45° FOV: 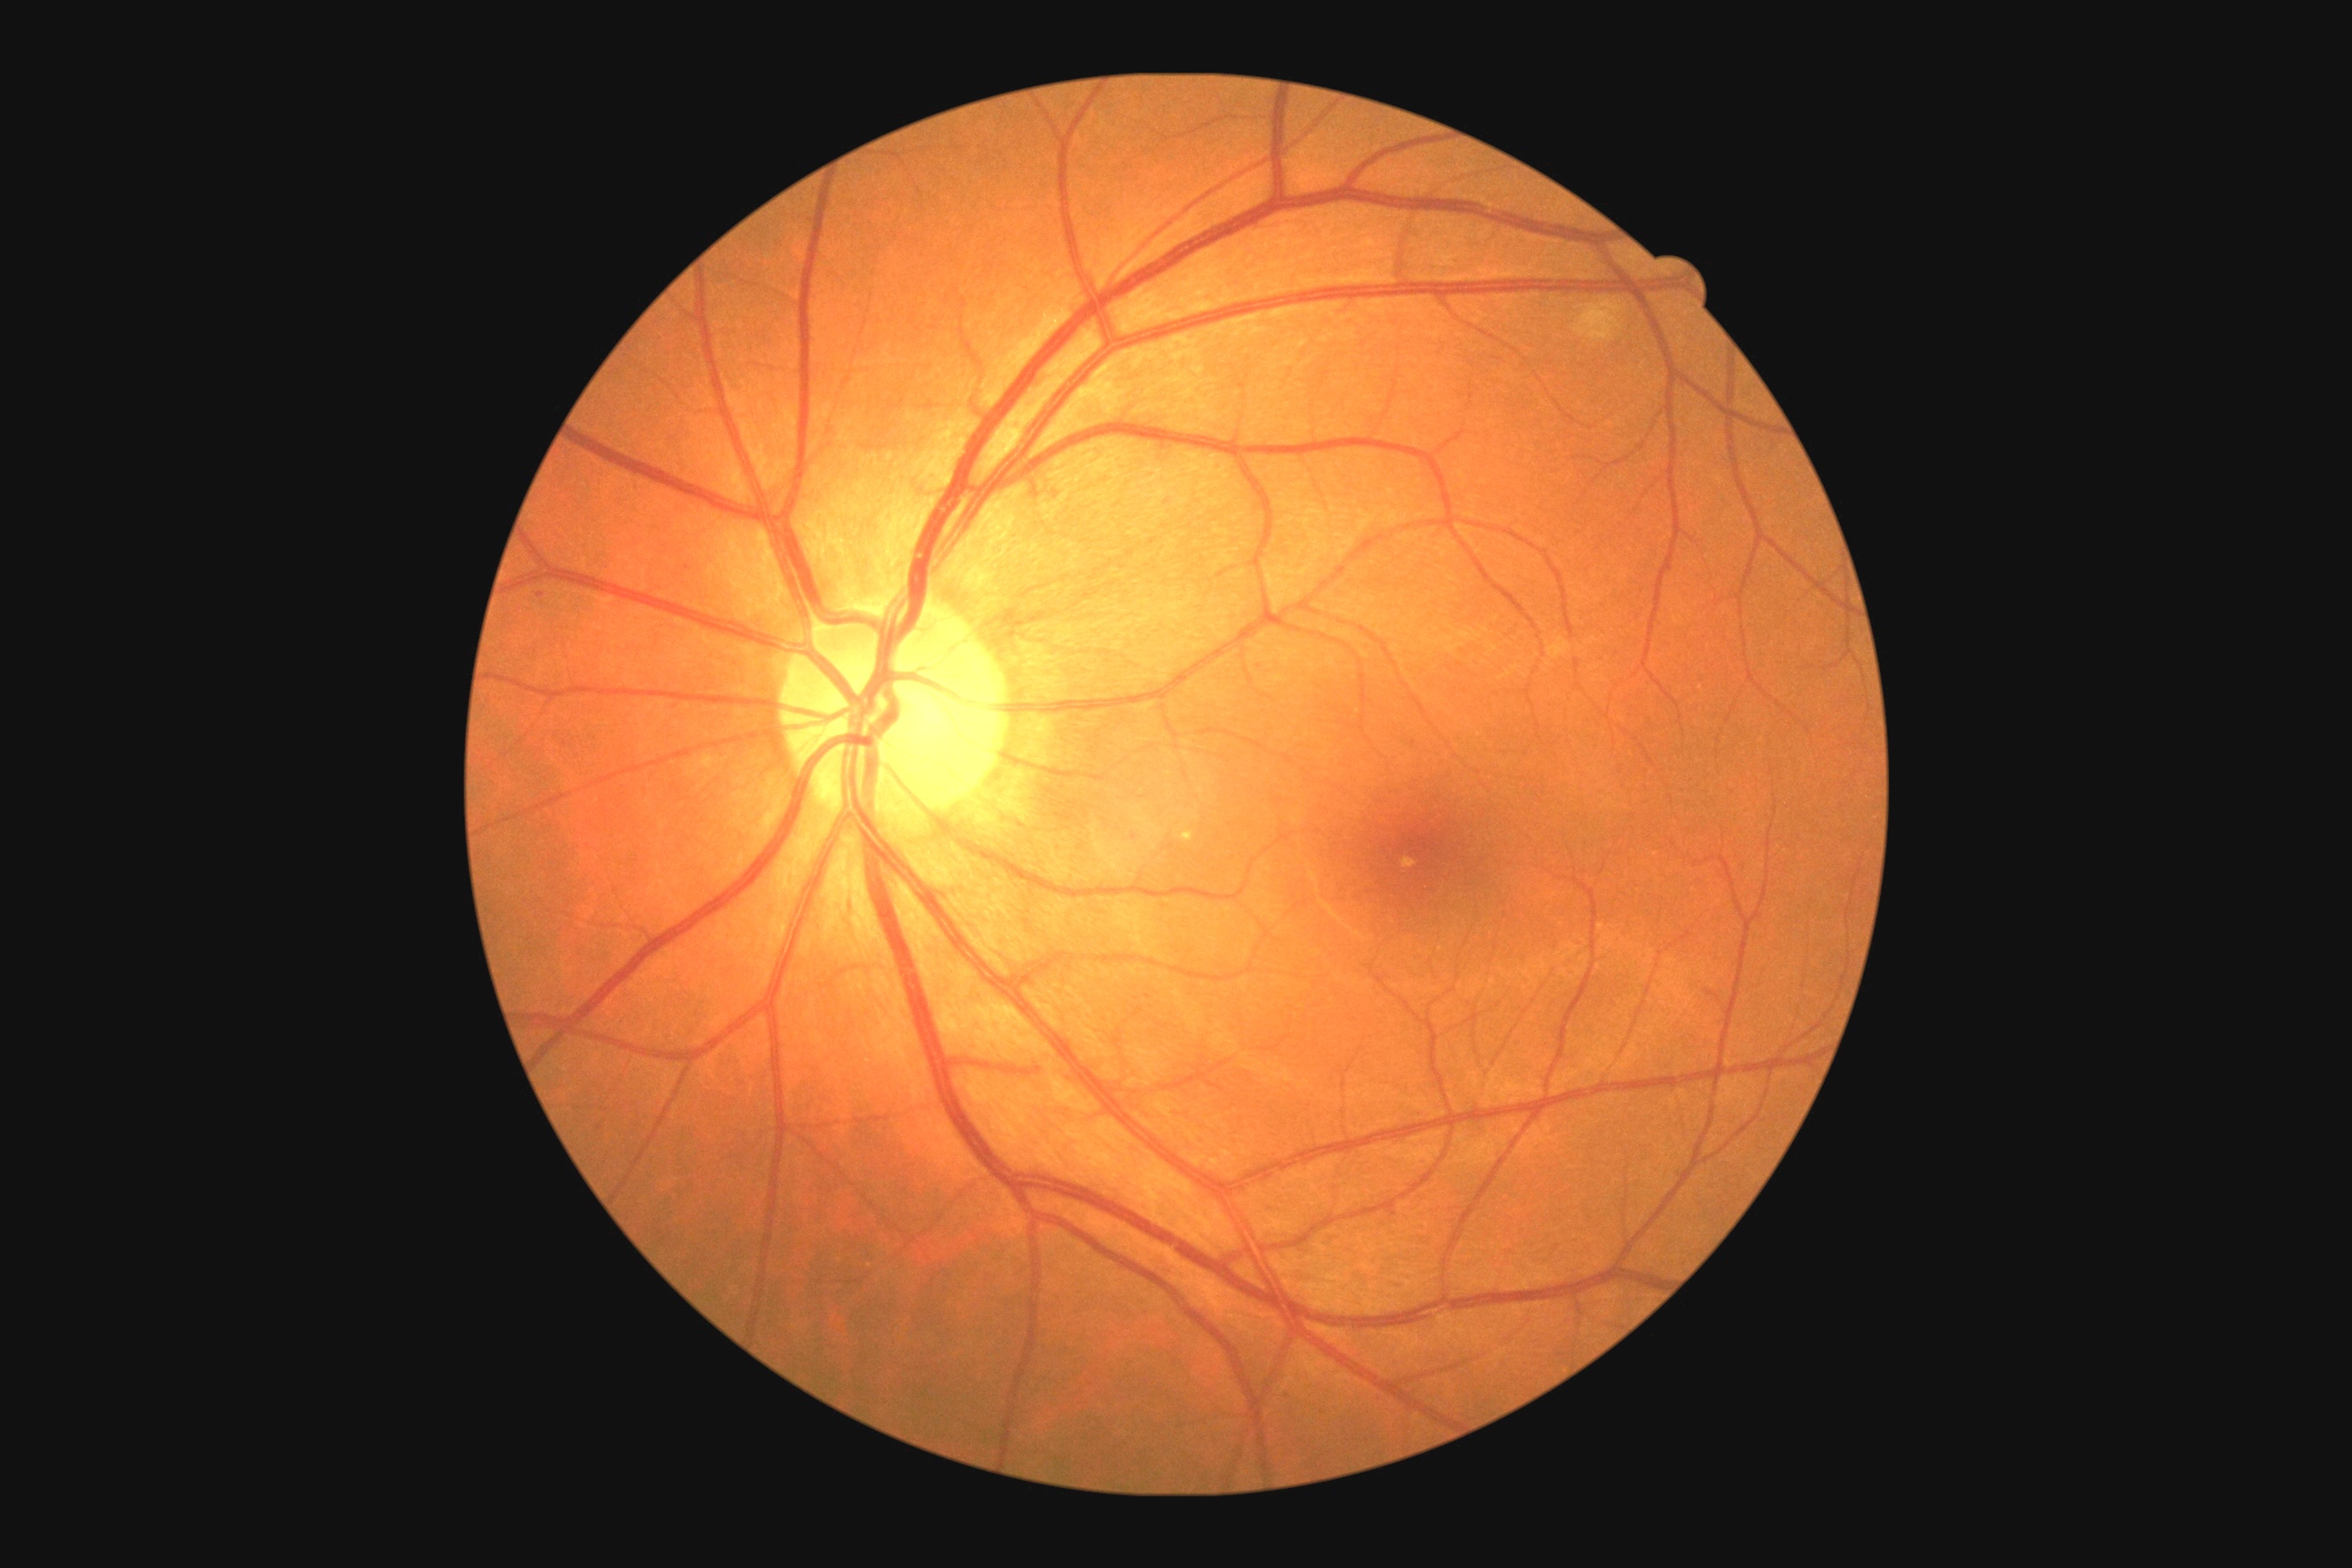
diabetic retinopathy: 2/4 — more than just microaneurysms but less than severe NPDR.